Pediatric wide-field fundus photograph — 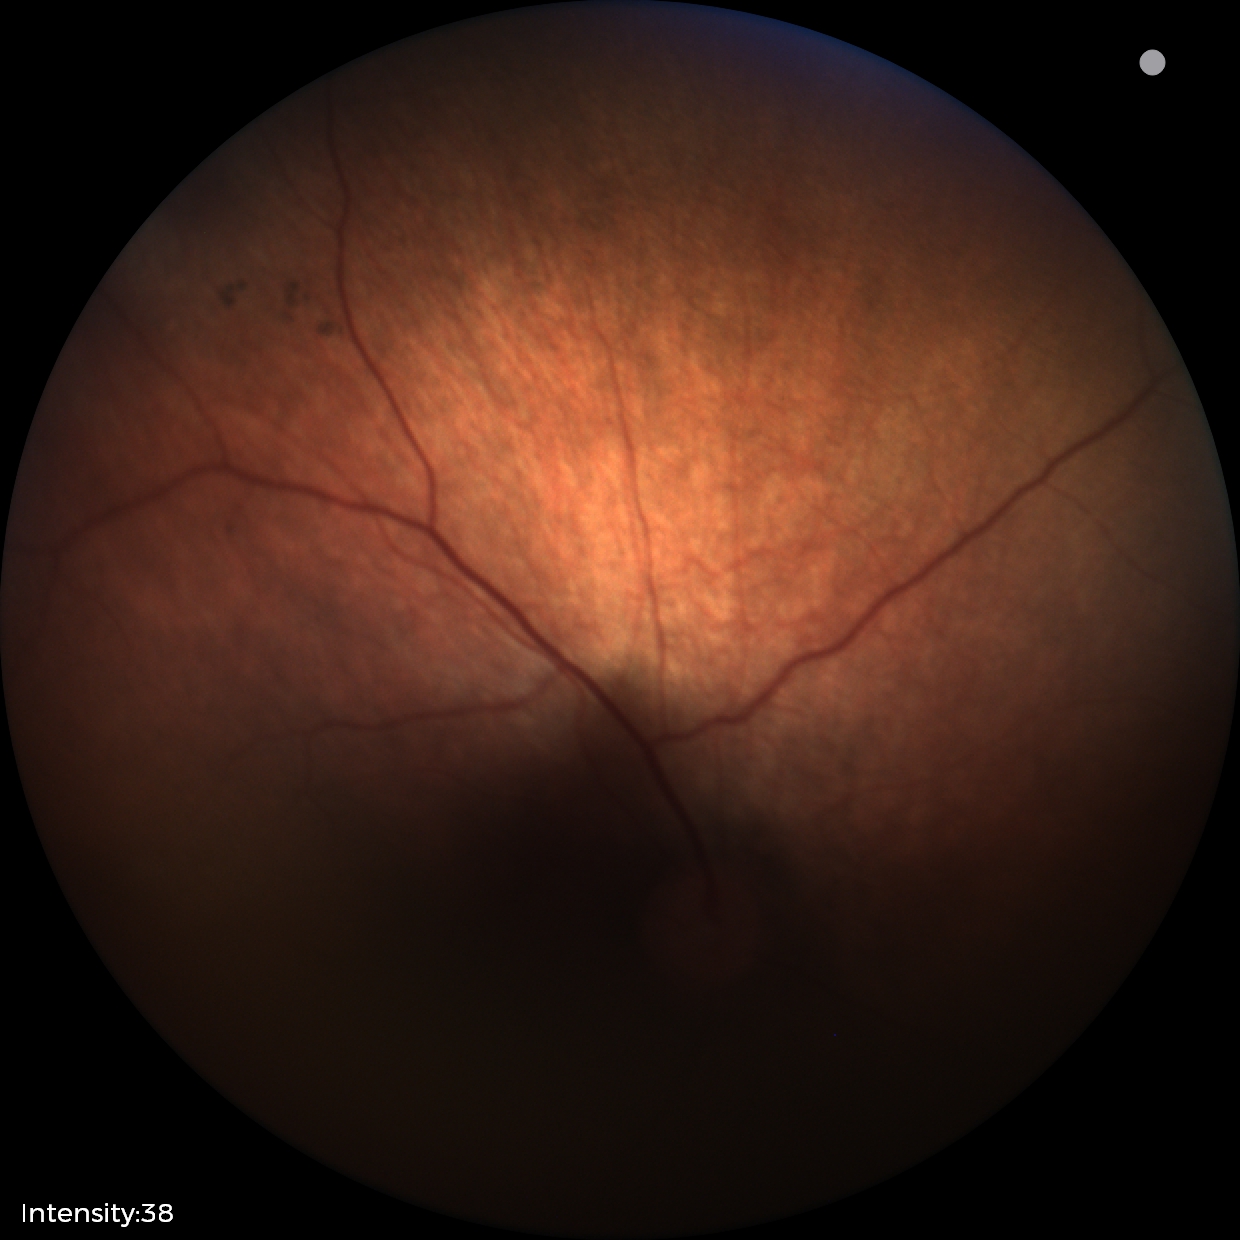
Physiological retinal appearance for postconceptual age.